Modified Davis grading — 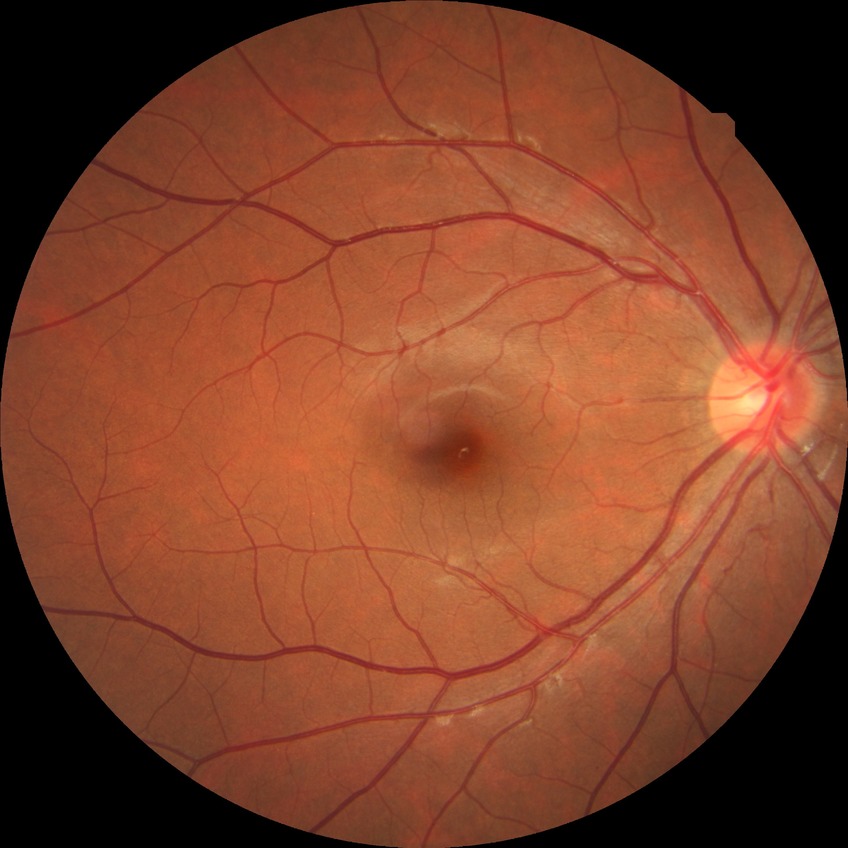

Diabetic retinopathy (DR): no diabetic retinopathy (NDR).